Retinal fundus photograph. NIDEK AFC-230. Davis DR grading — 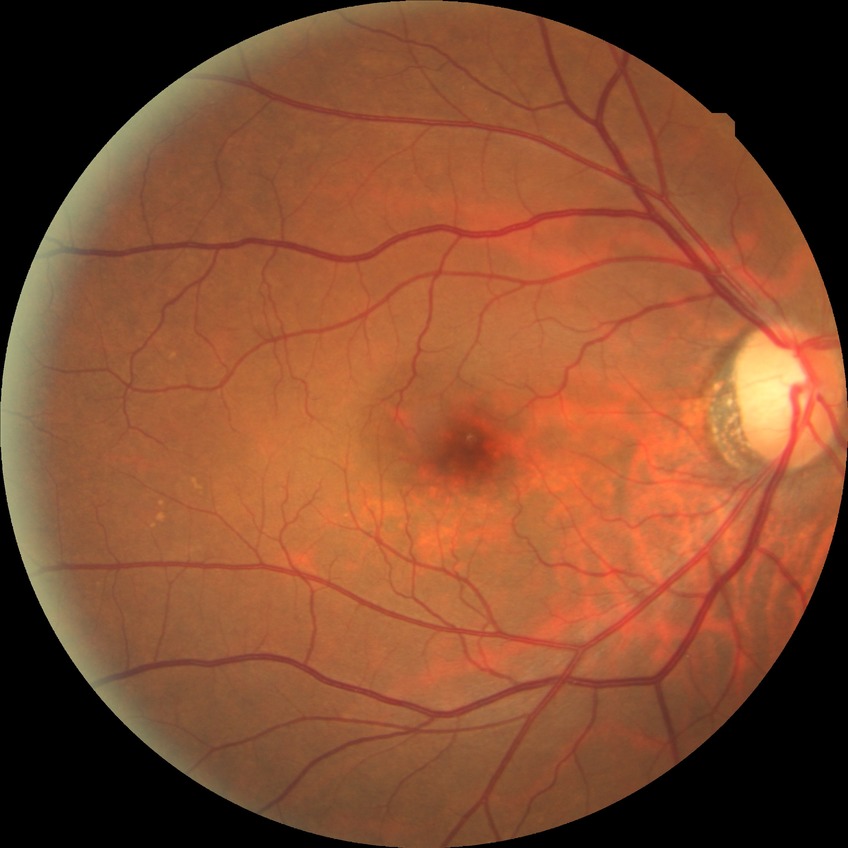 DR stage@NDR, DR impression@no apparent DR.